848x848:
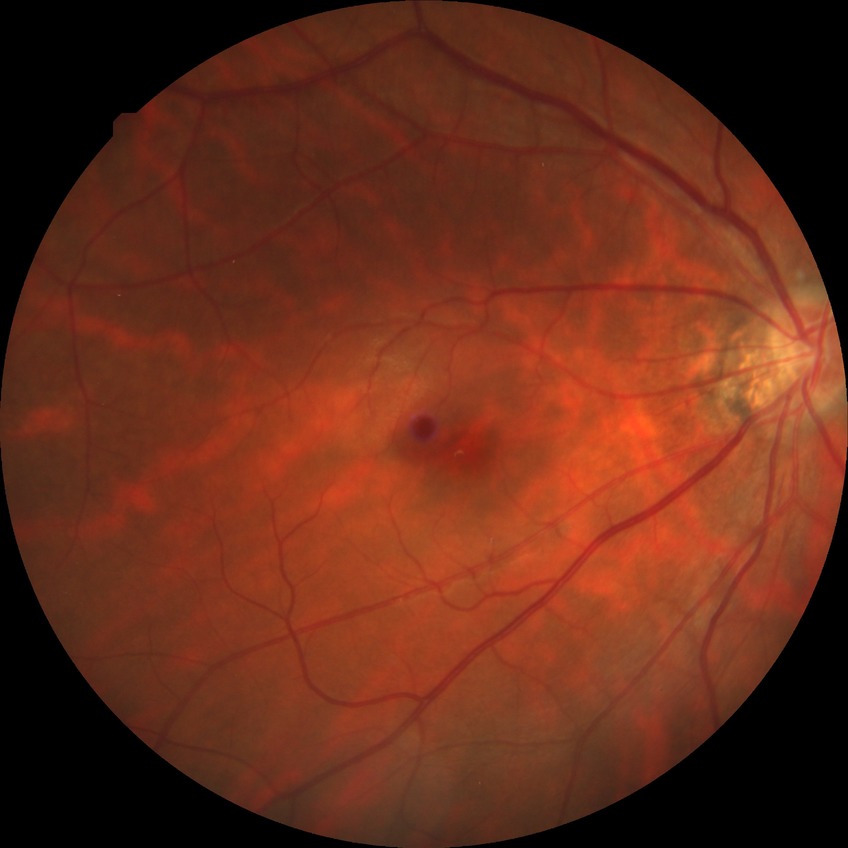
DR is NDR.